45° field of view, 1932 by 1932 pixels — 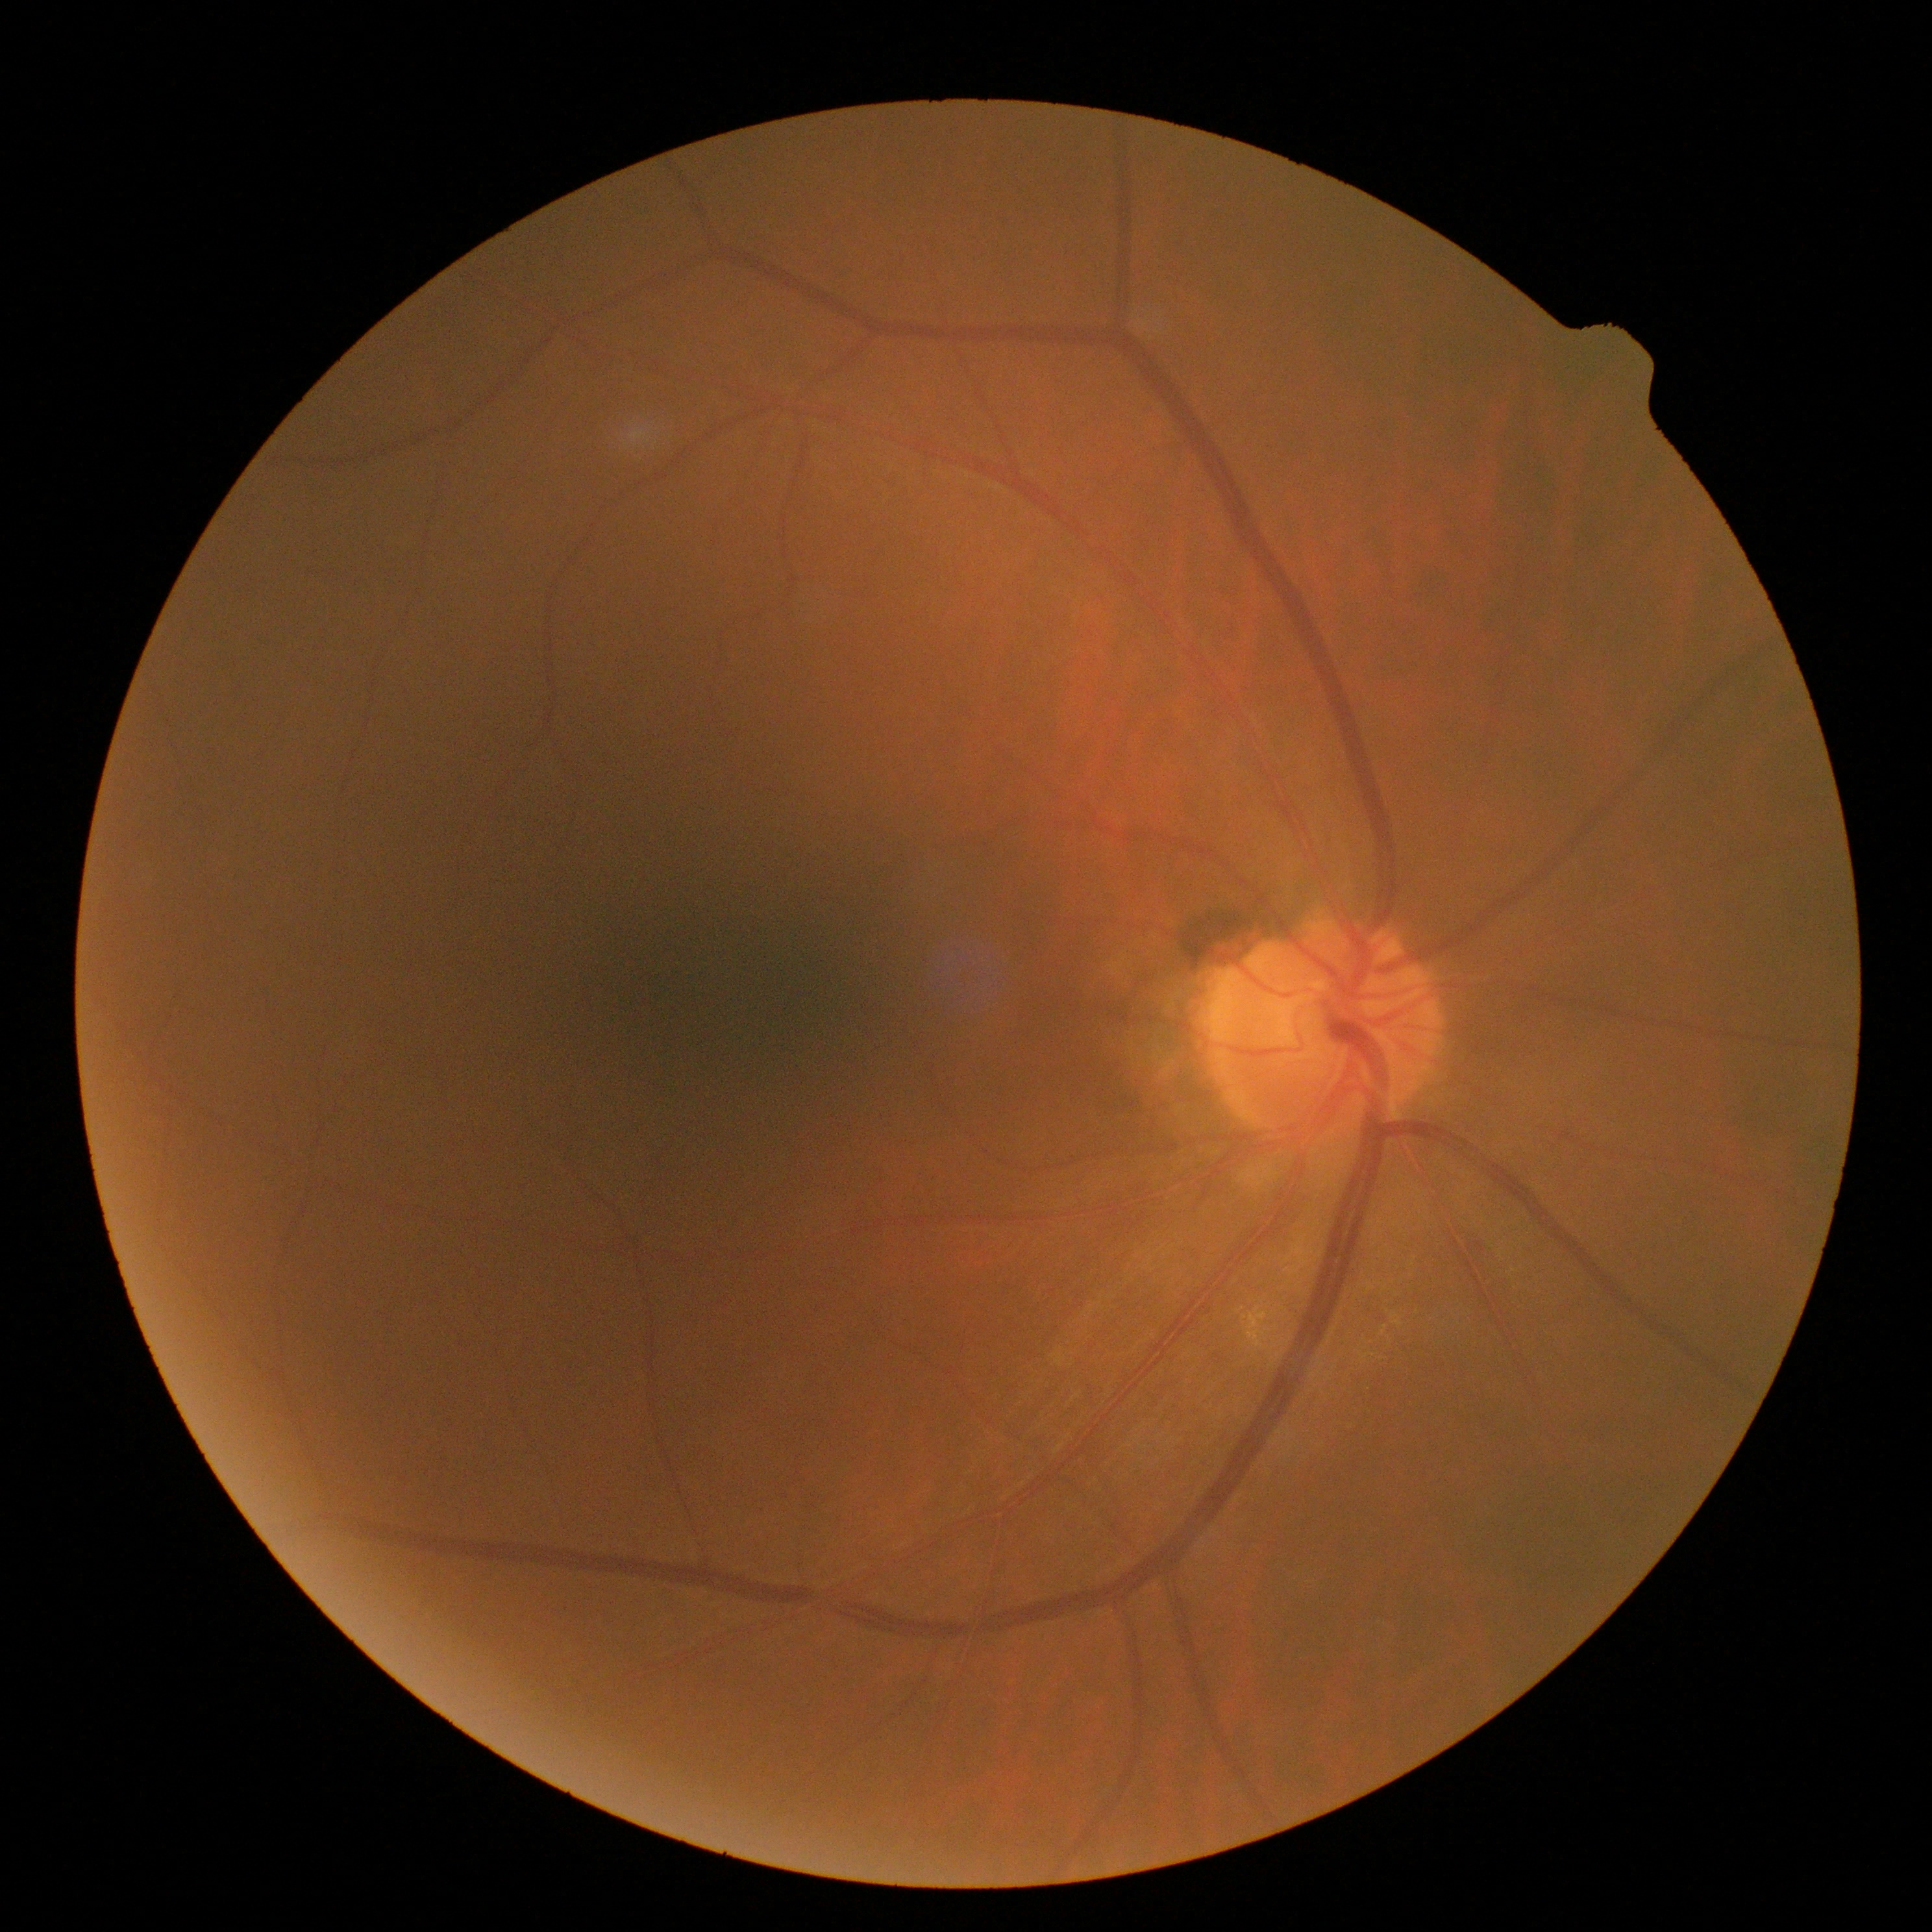 No diabetic retinal disease findings. Retinopathy grade is no apparent diabetic retinopathy (0).